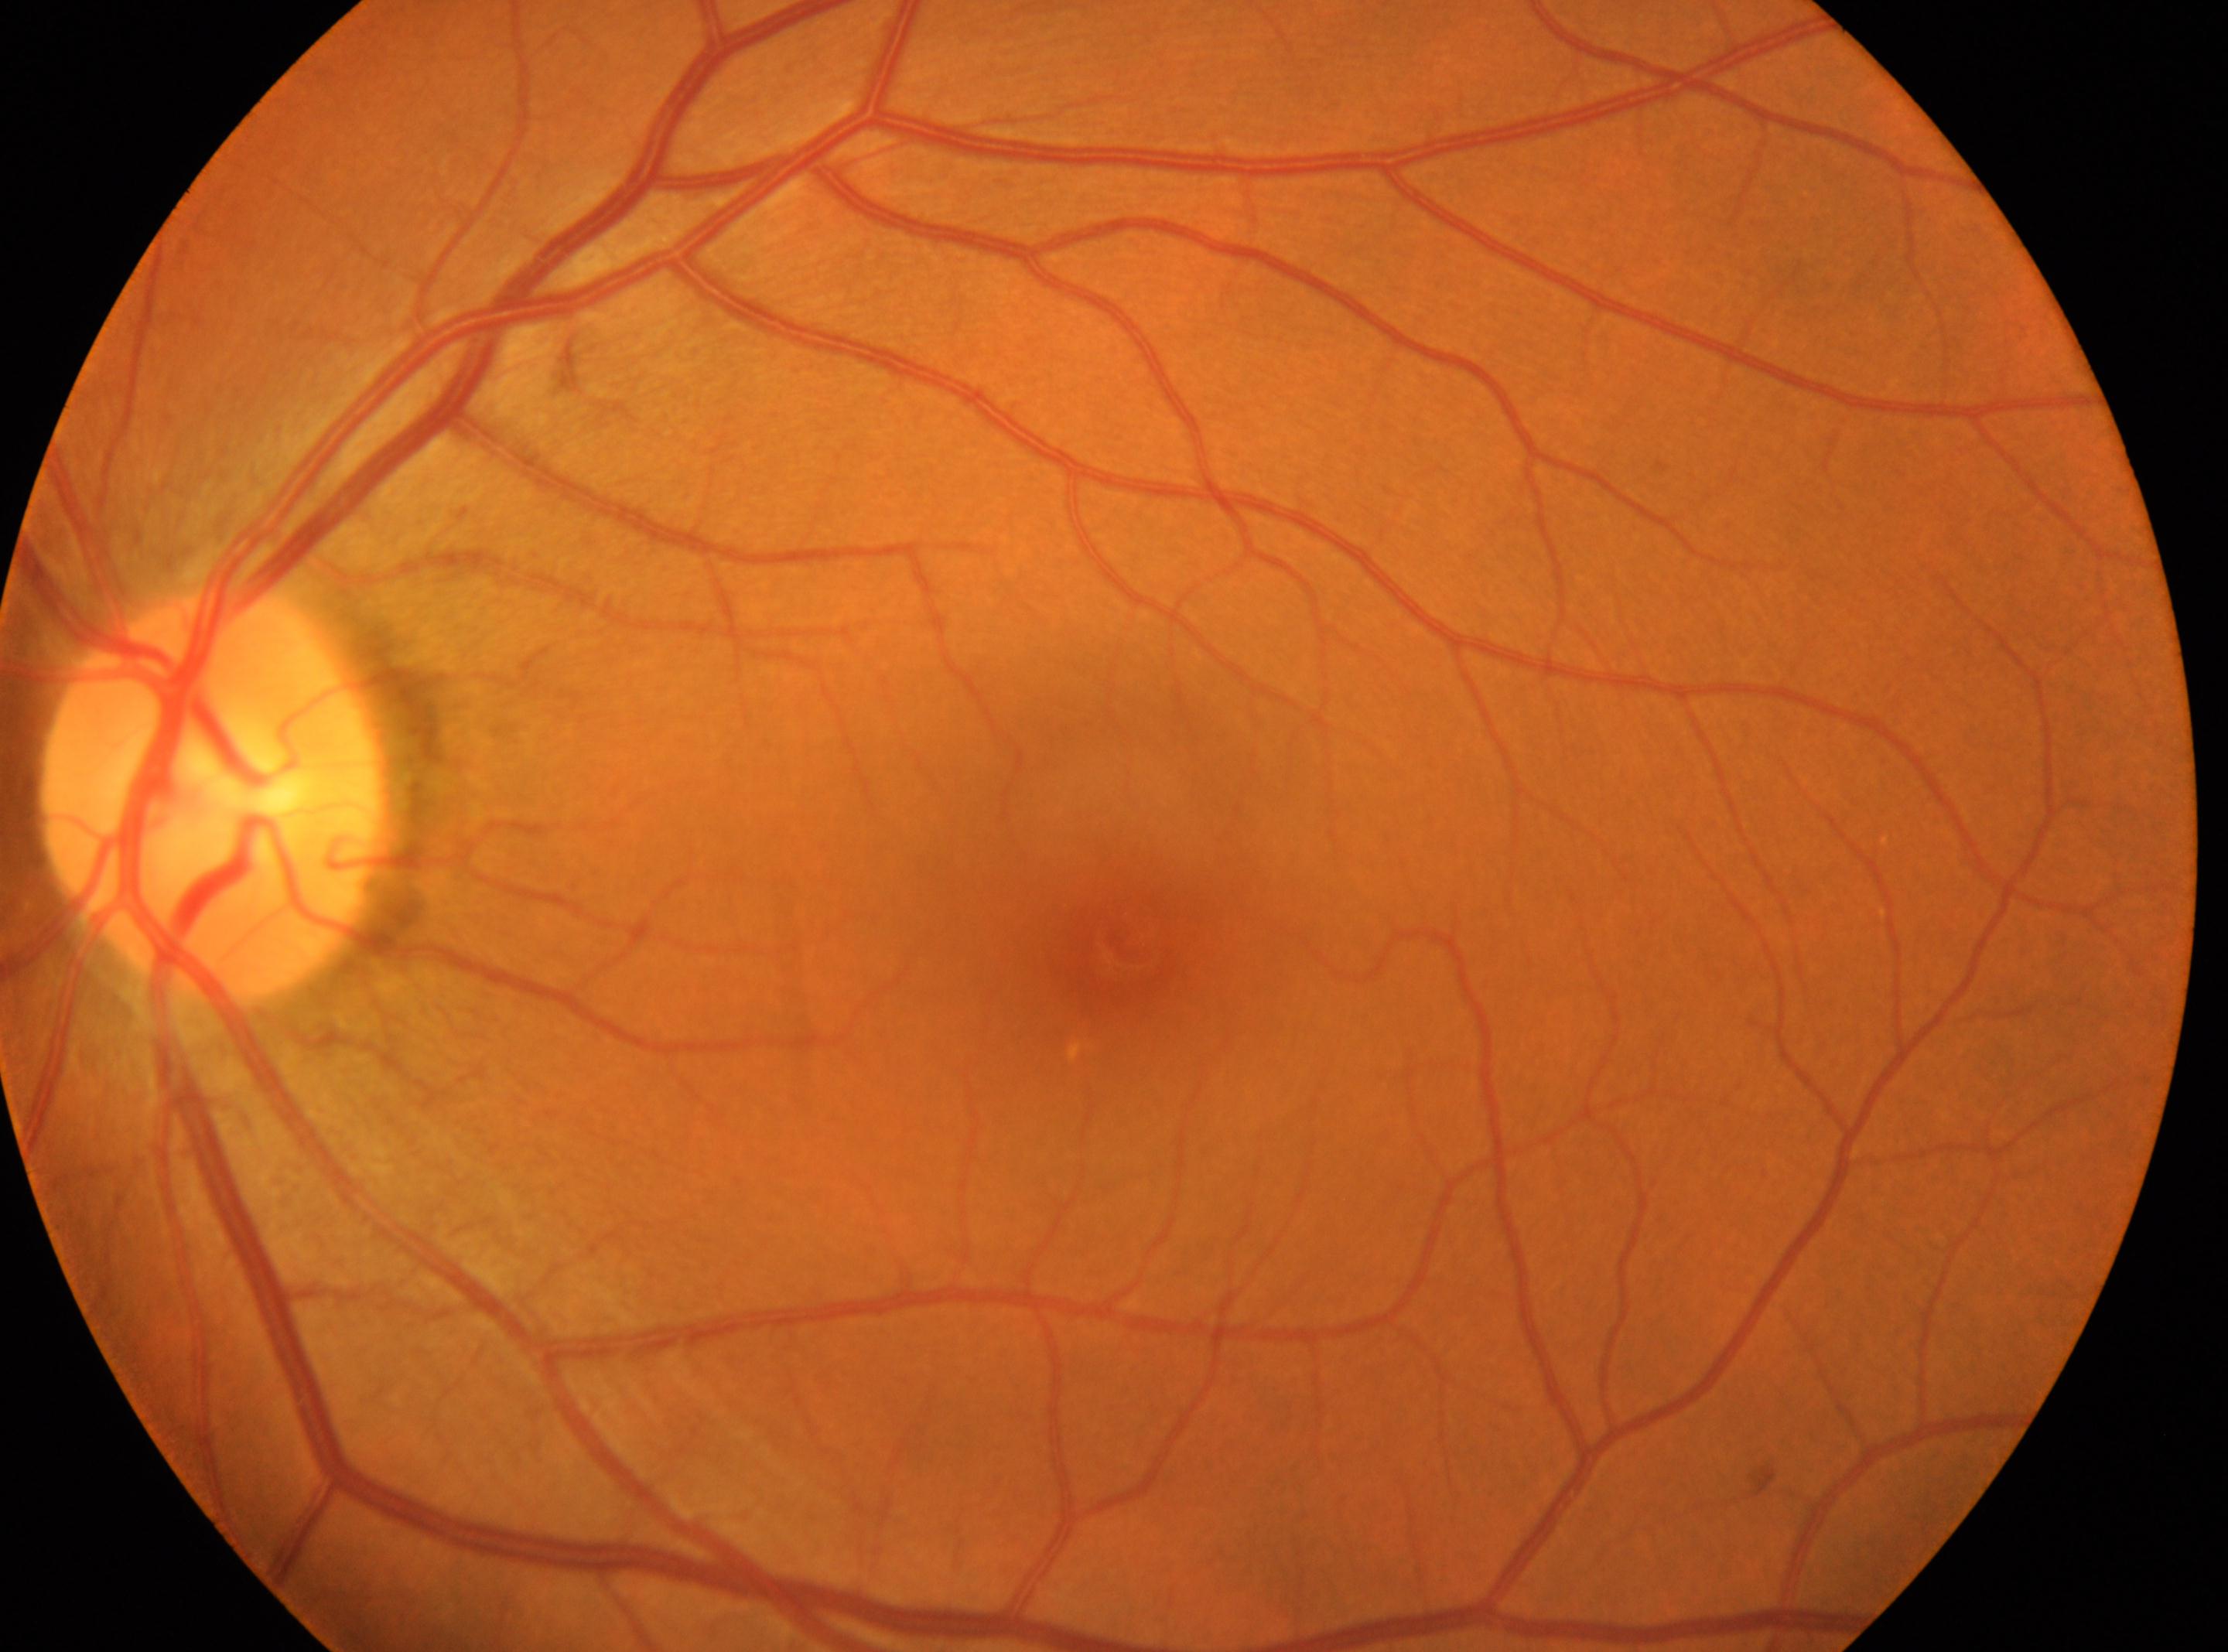 diabetic retinopathy (DR)=grade 0 (no apparent retinopathy) — no visible signs of diabetic retinopathy | OS | disc center=(x: 217, y: 794) | fovea=(x: 1123, y: 948).